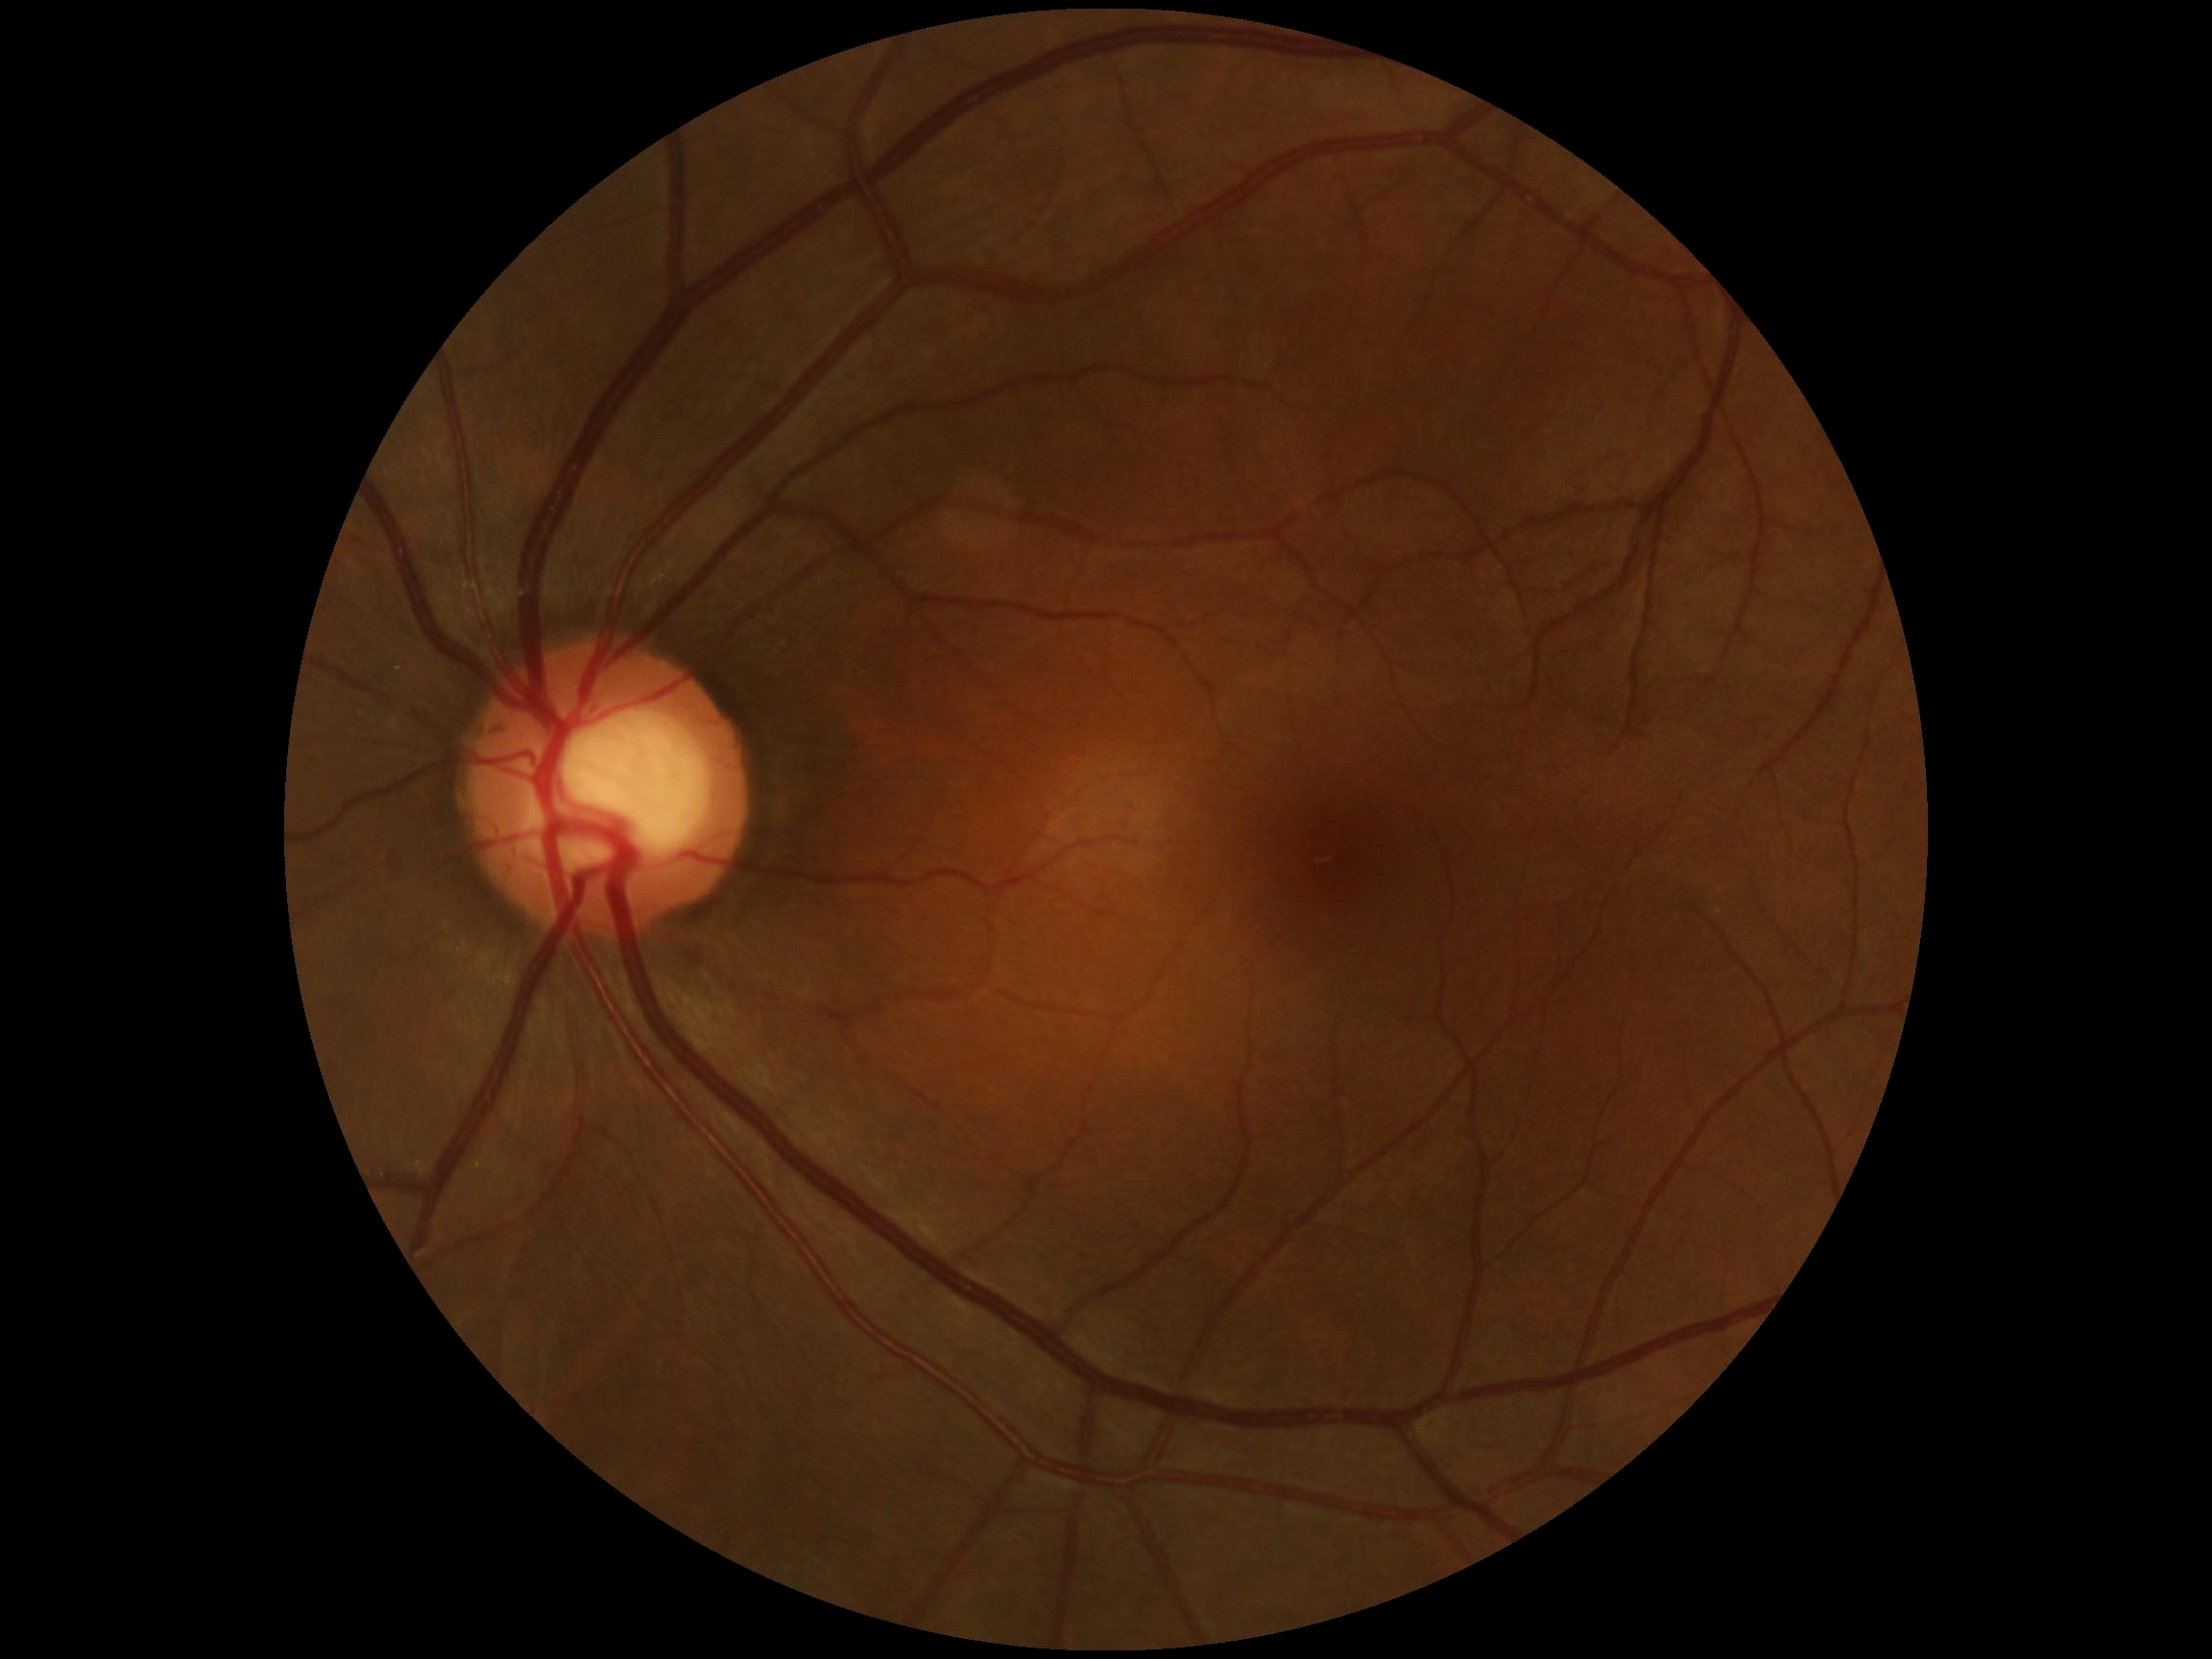
{
  "dr_grade": "0/4"
}